Dilated-pupil acquisition. Field includes the optic disc and macula: 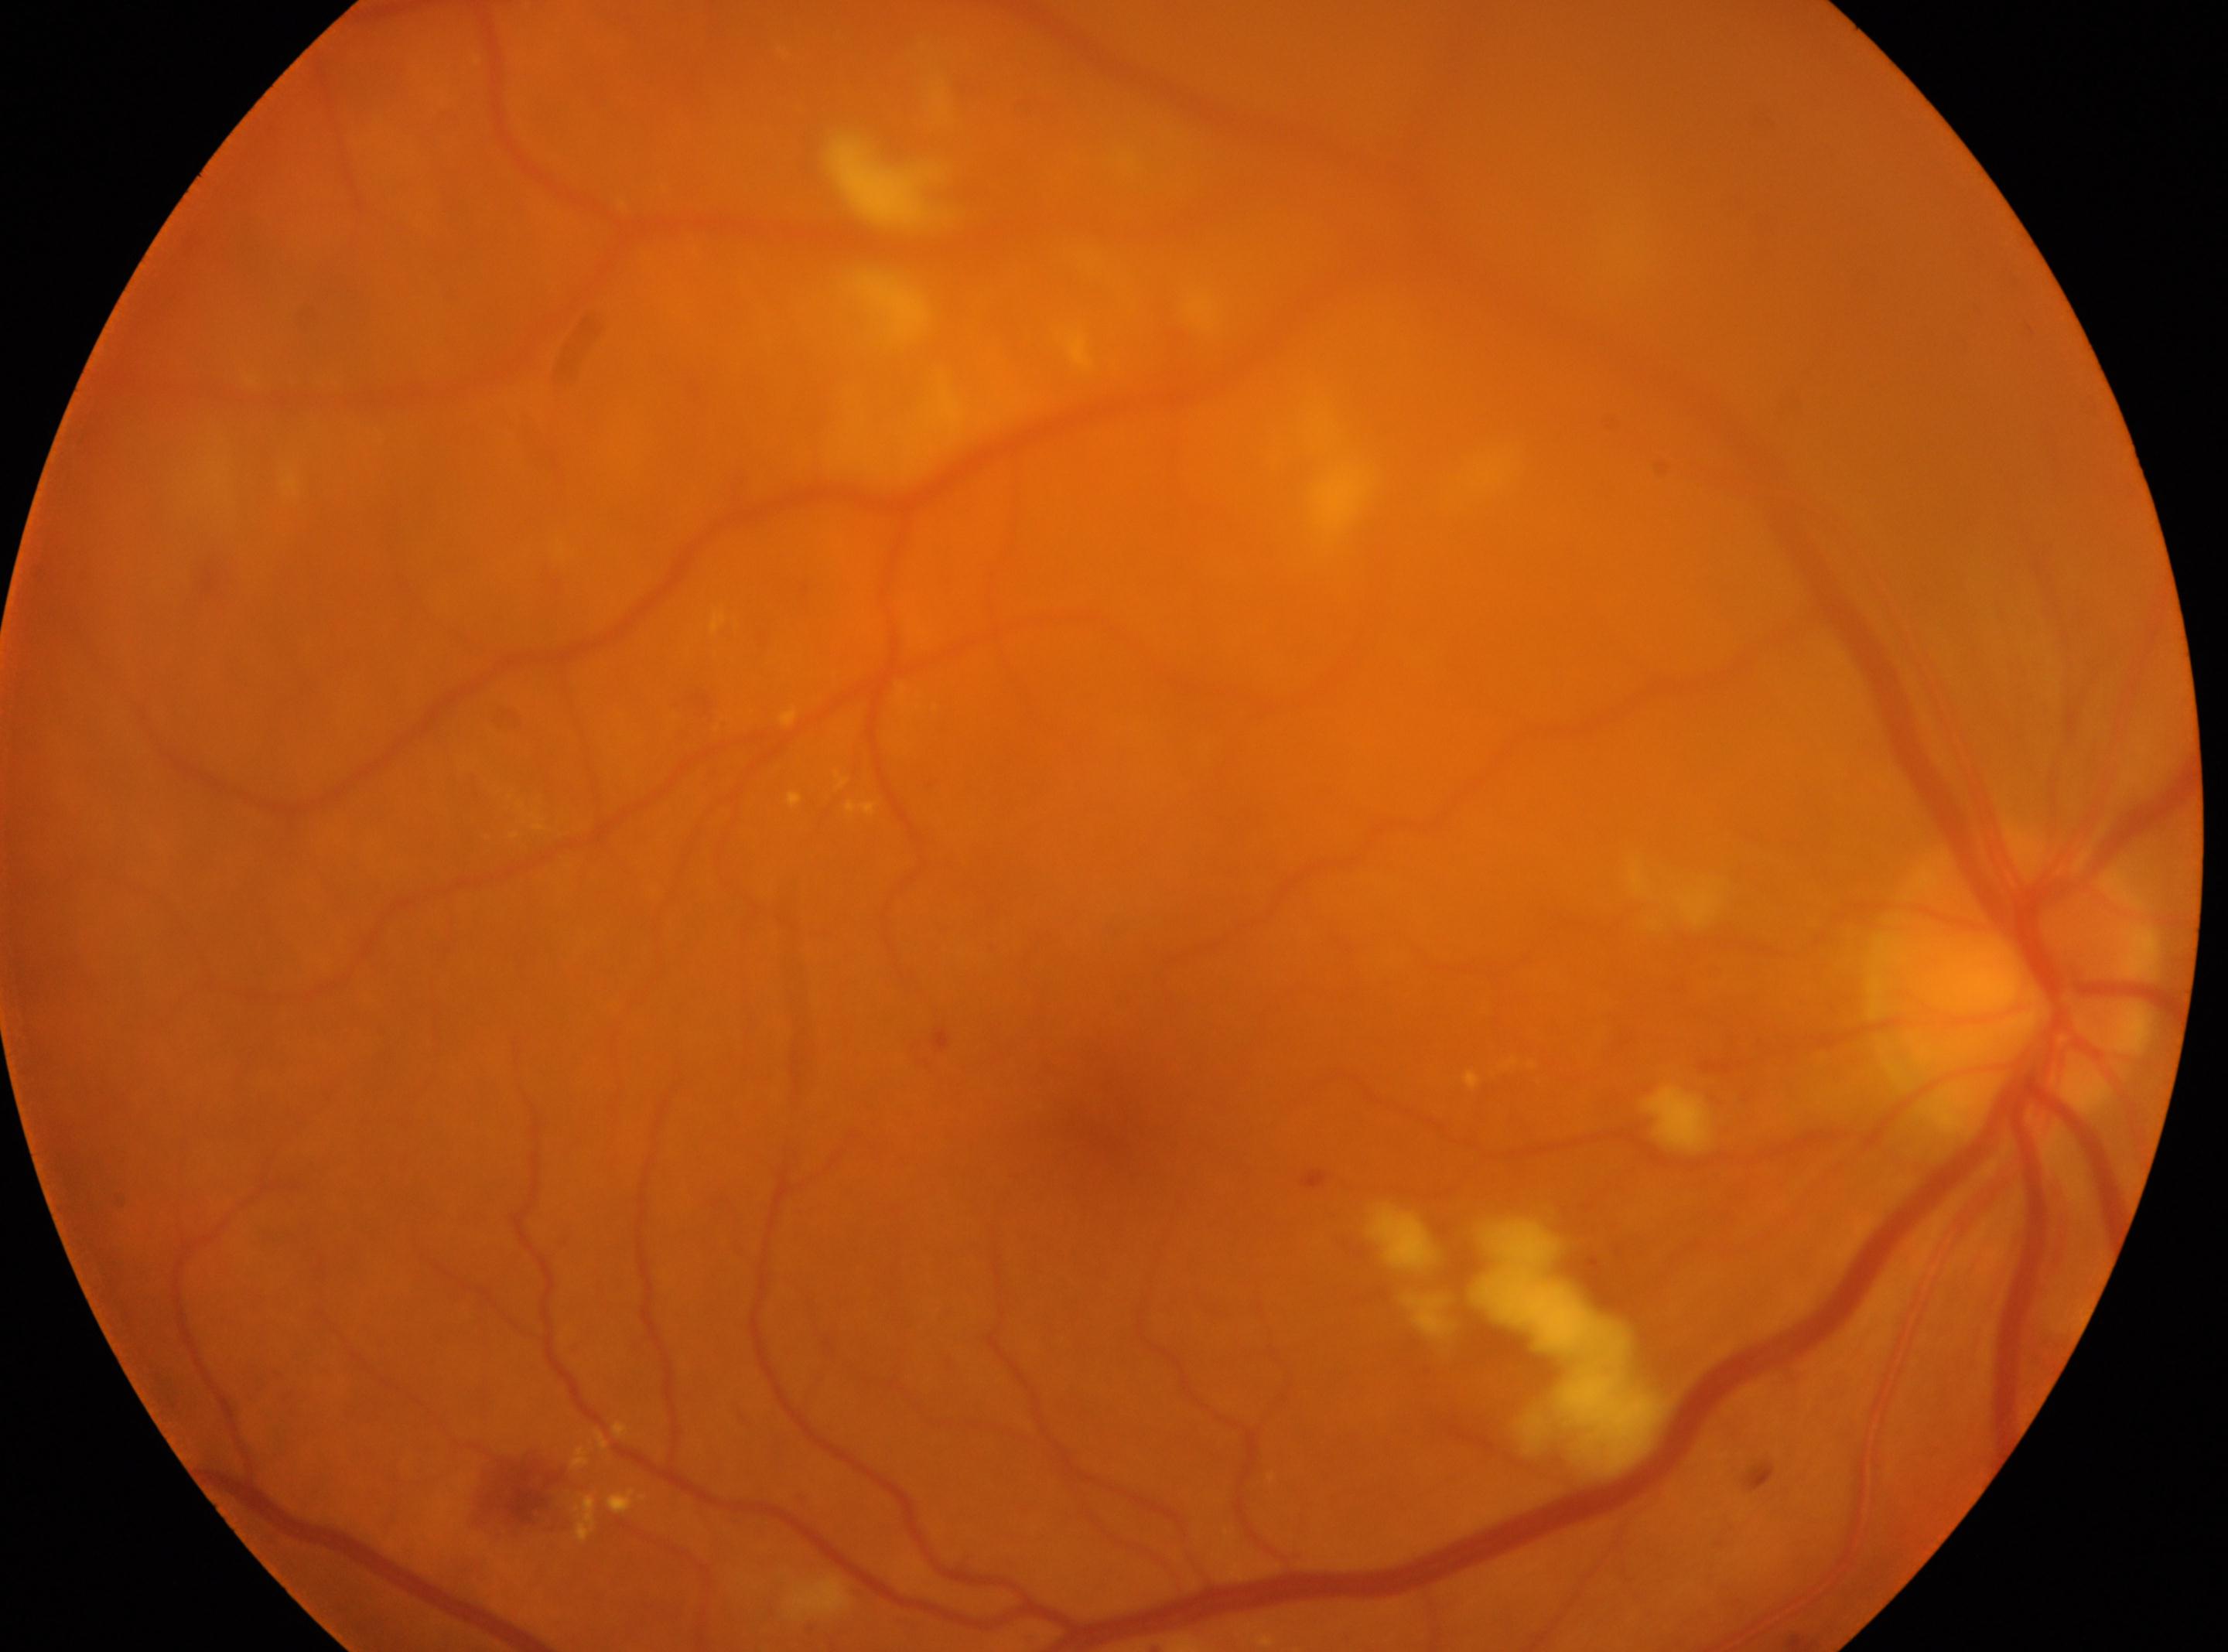

Findings:
- optic disc center — [2011, 982]
- laterality — right
- DR class — non-proliferative diabetic retinopathy
- fovea centralis — [1106, 1112]
- DR stage — 2/4